Without pupil dilation
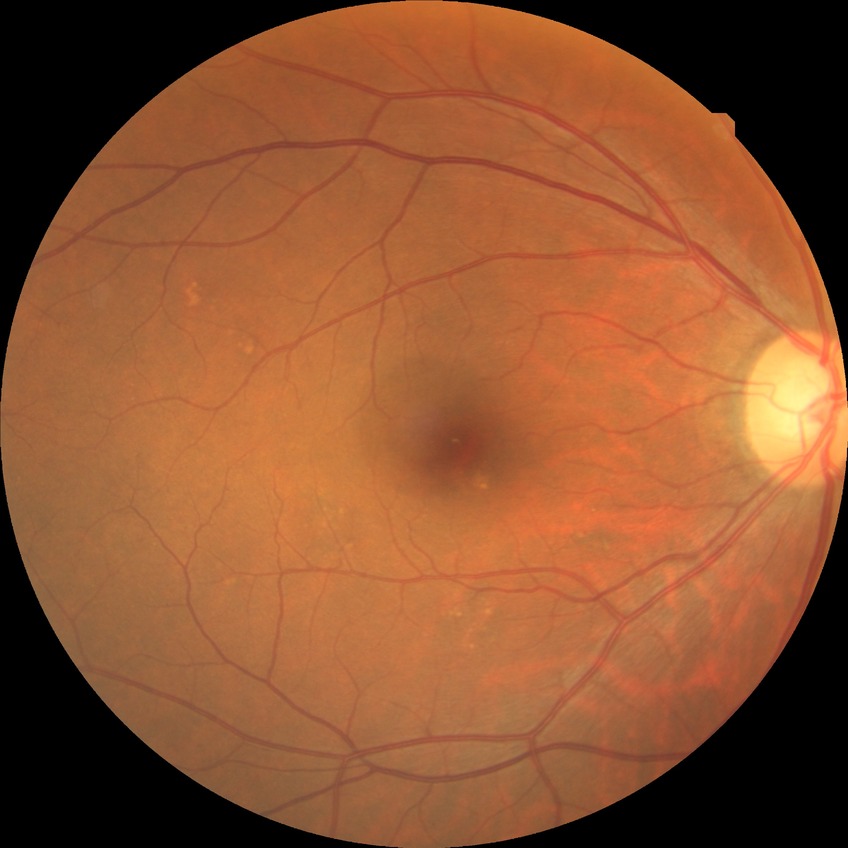 Retinopathy stage is no diabetic retinopathy.